Image size 2352x1568: 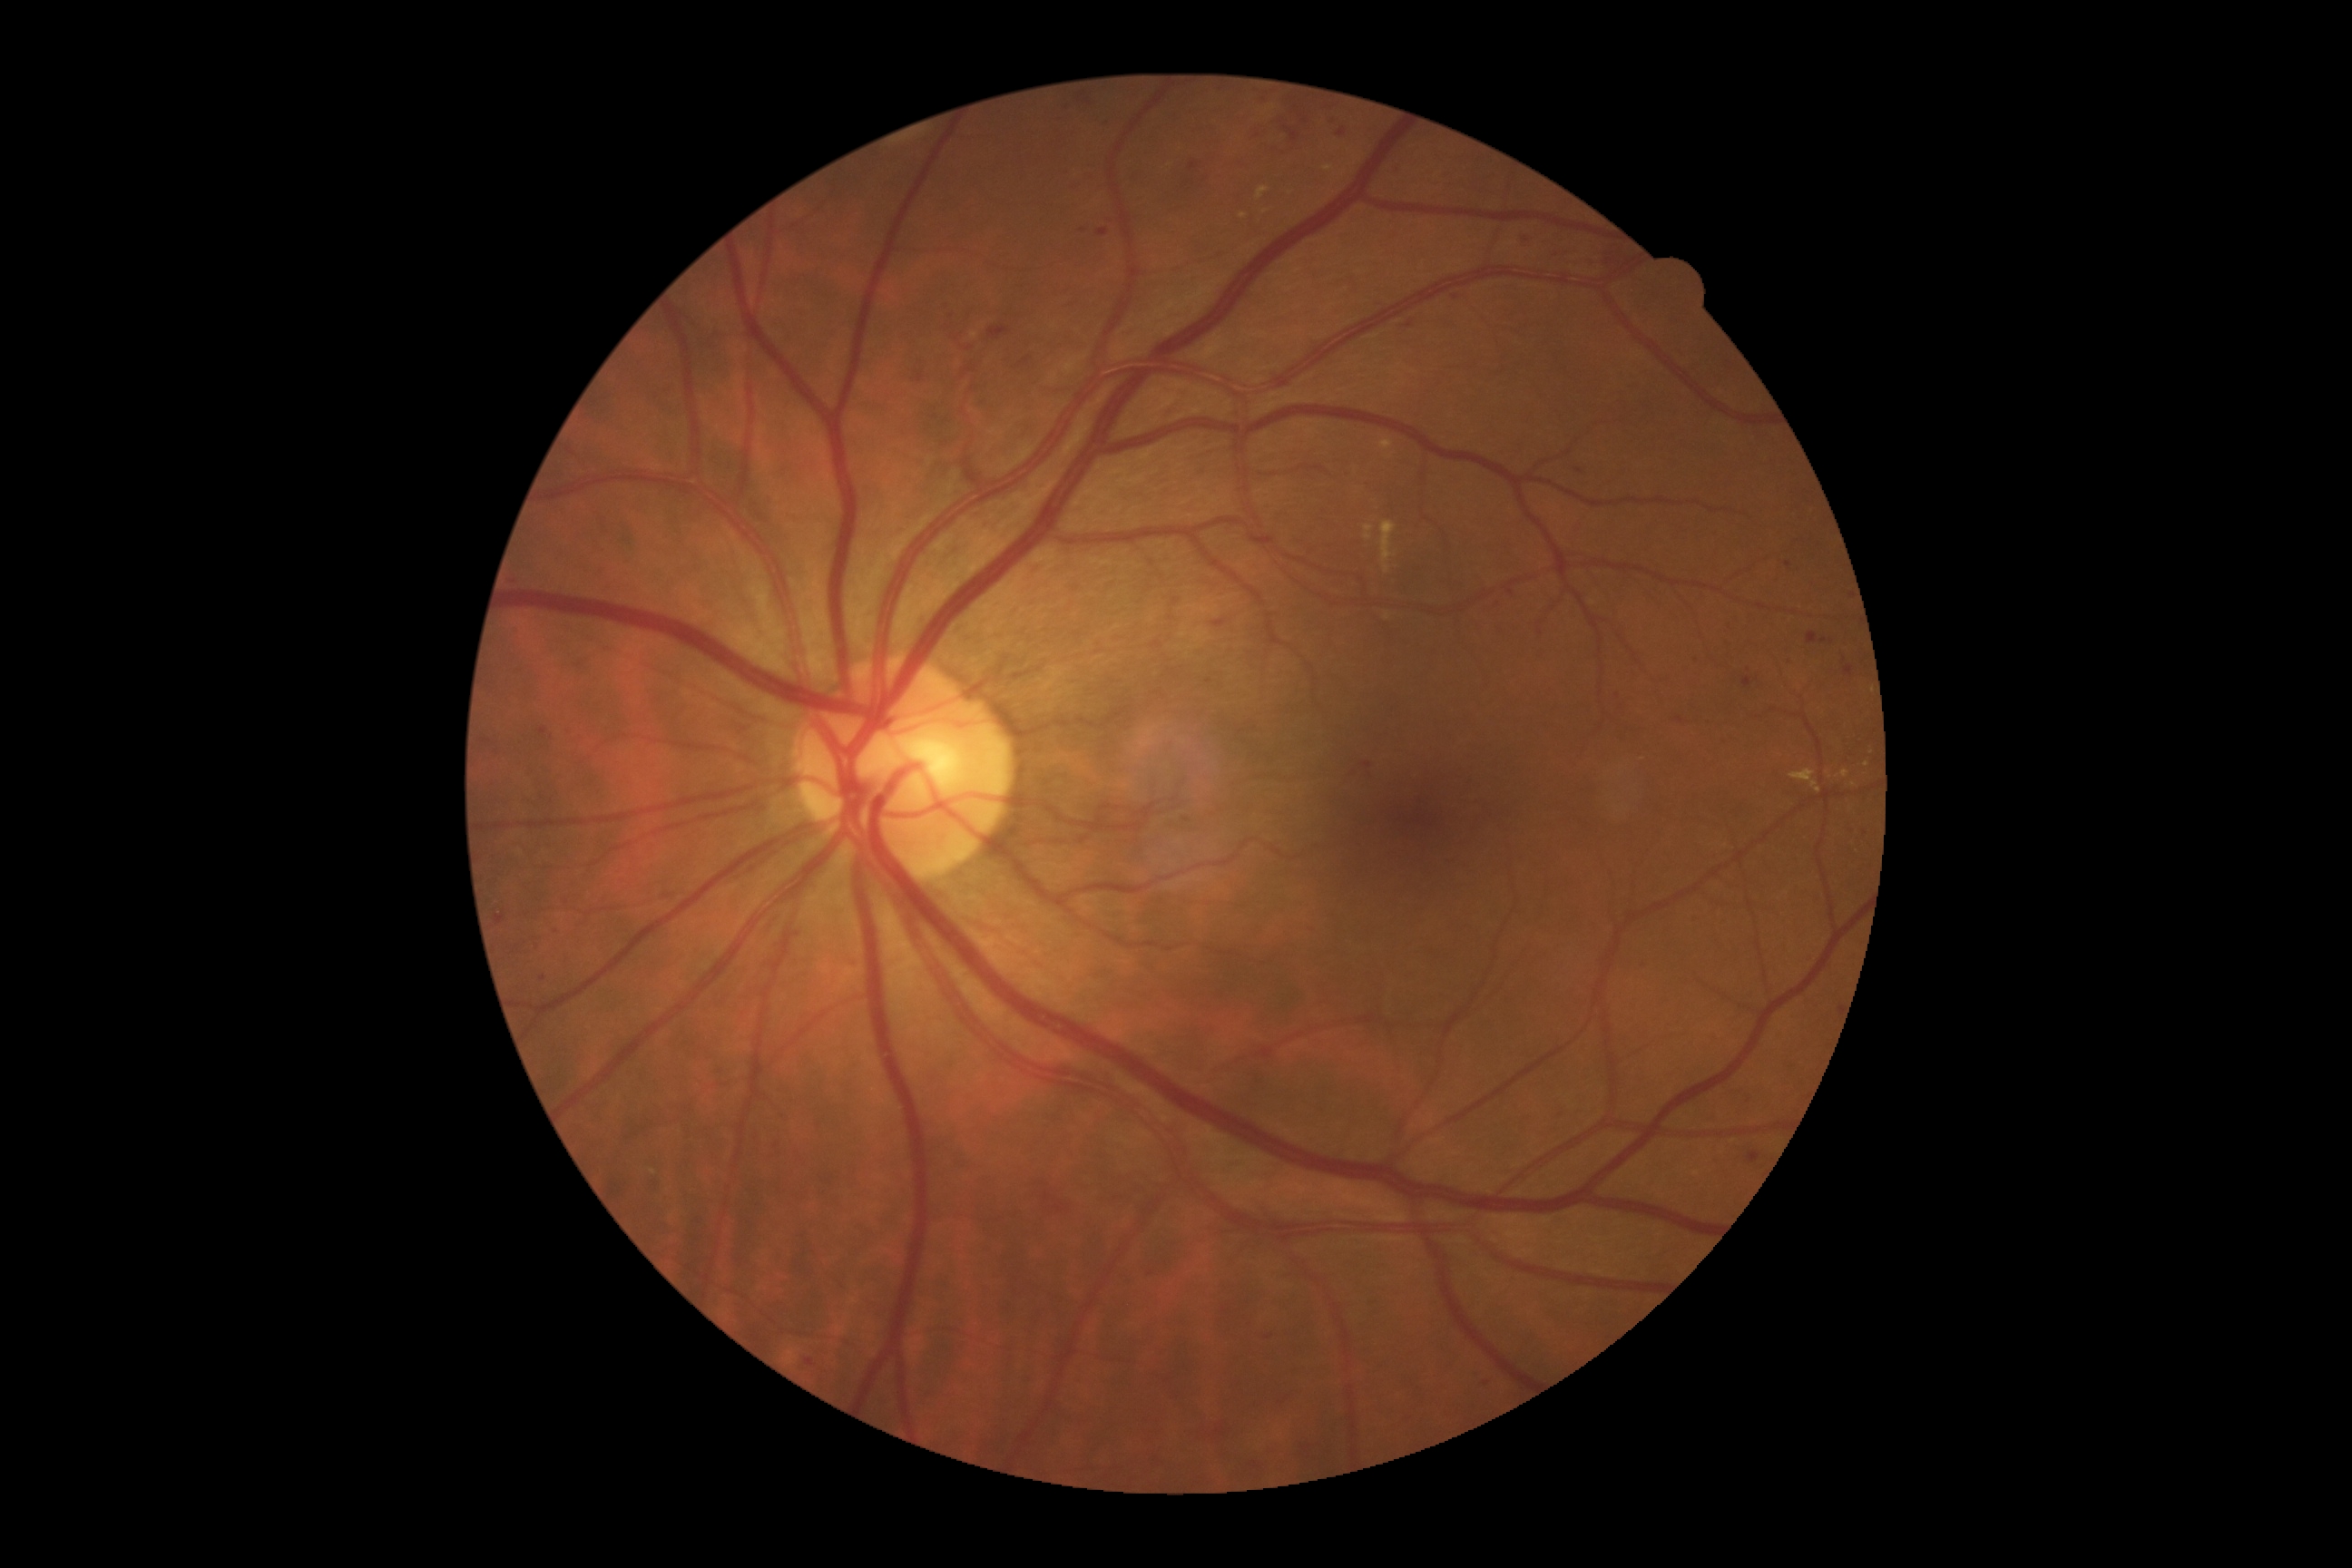

Diabetic retinopathy (DR): grade 2 (moderate NPDR)
Representative lesions:
- hemorrhages (HEs) (continued): [left=1518, top=235, right=1533, bottom=250], [left=1061, top=166, right=1072, bottom=179], [left=1246, top=1458, right=1268, bottom=1476], [left=689, top=1213, right=705, bottom=1224], [left=916, top=360, right=928, bottom=382], [left=562, top=725, right=576, bottom=736], [left=1493, top=600, right=1502, bottom=611], [left=921, top=1389, right=937, bottom=1404], [left=1030, top=1182, right=1079, bottom=1219], [left=1193, top=1418, right=1230, bottom=1442], [left=1375, top=300, right=1387, bottom=308], [left=1551, top=246, right=1578, bottom=259], [left=1213, top=620, right=1226, bottom=629], [left=540, top=727, right=547, bottom=736], [left=1845, top=827, right=1854, bottom=834]
- Additional small HEs near (972, 389), (543, 980), (1789, 565)